2352x1568px · color fundus photograph.
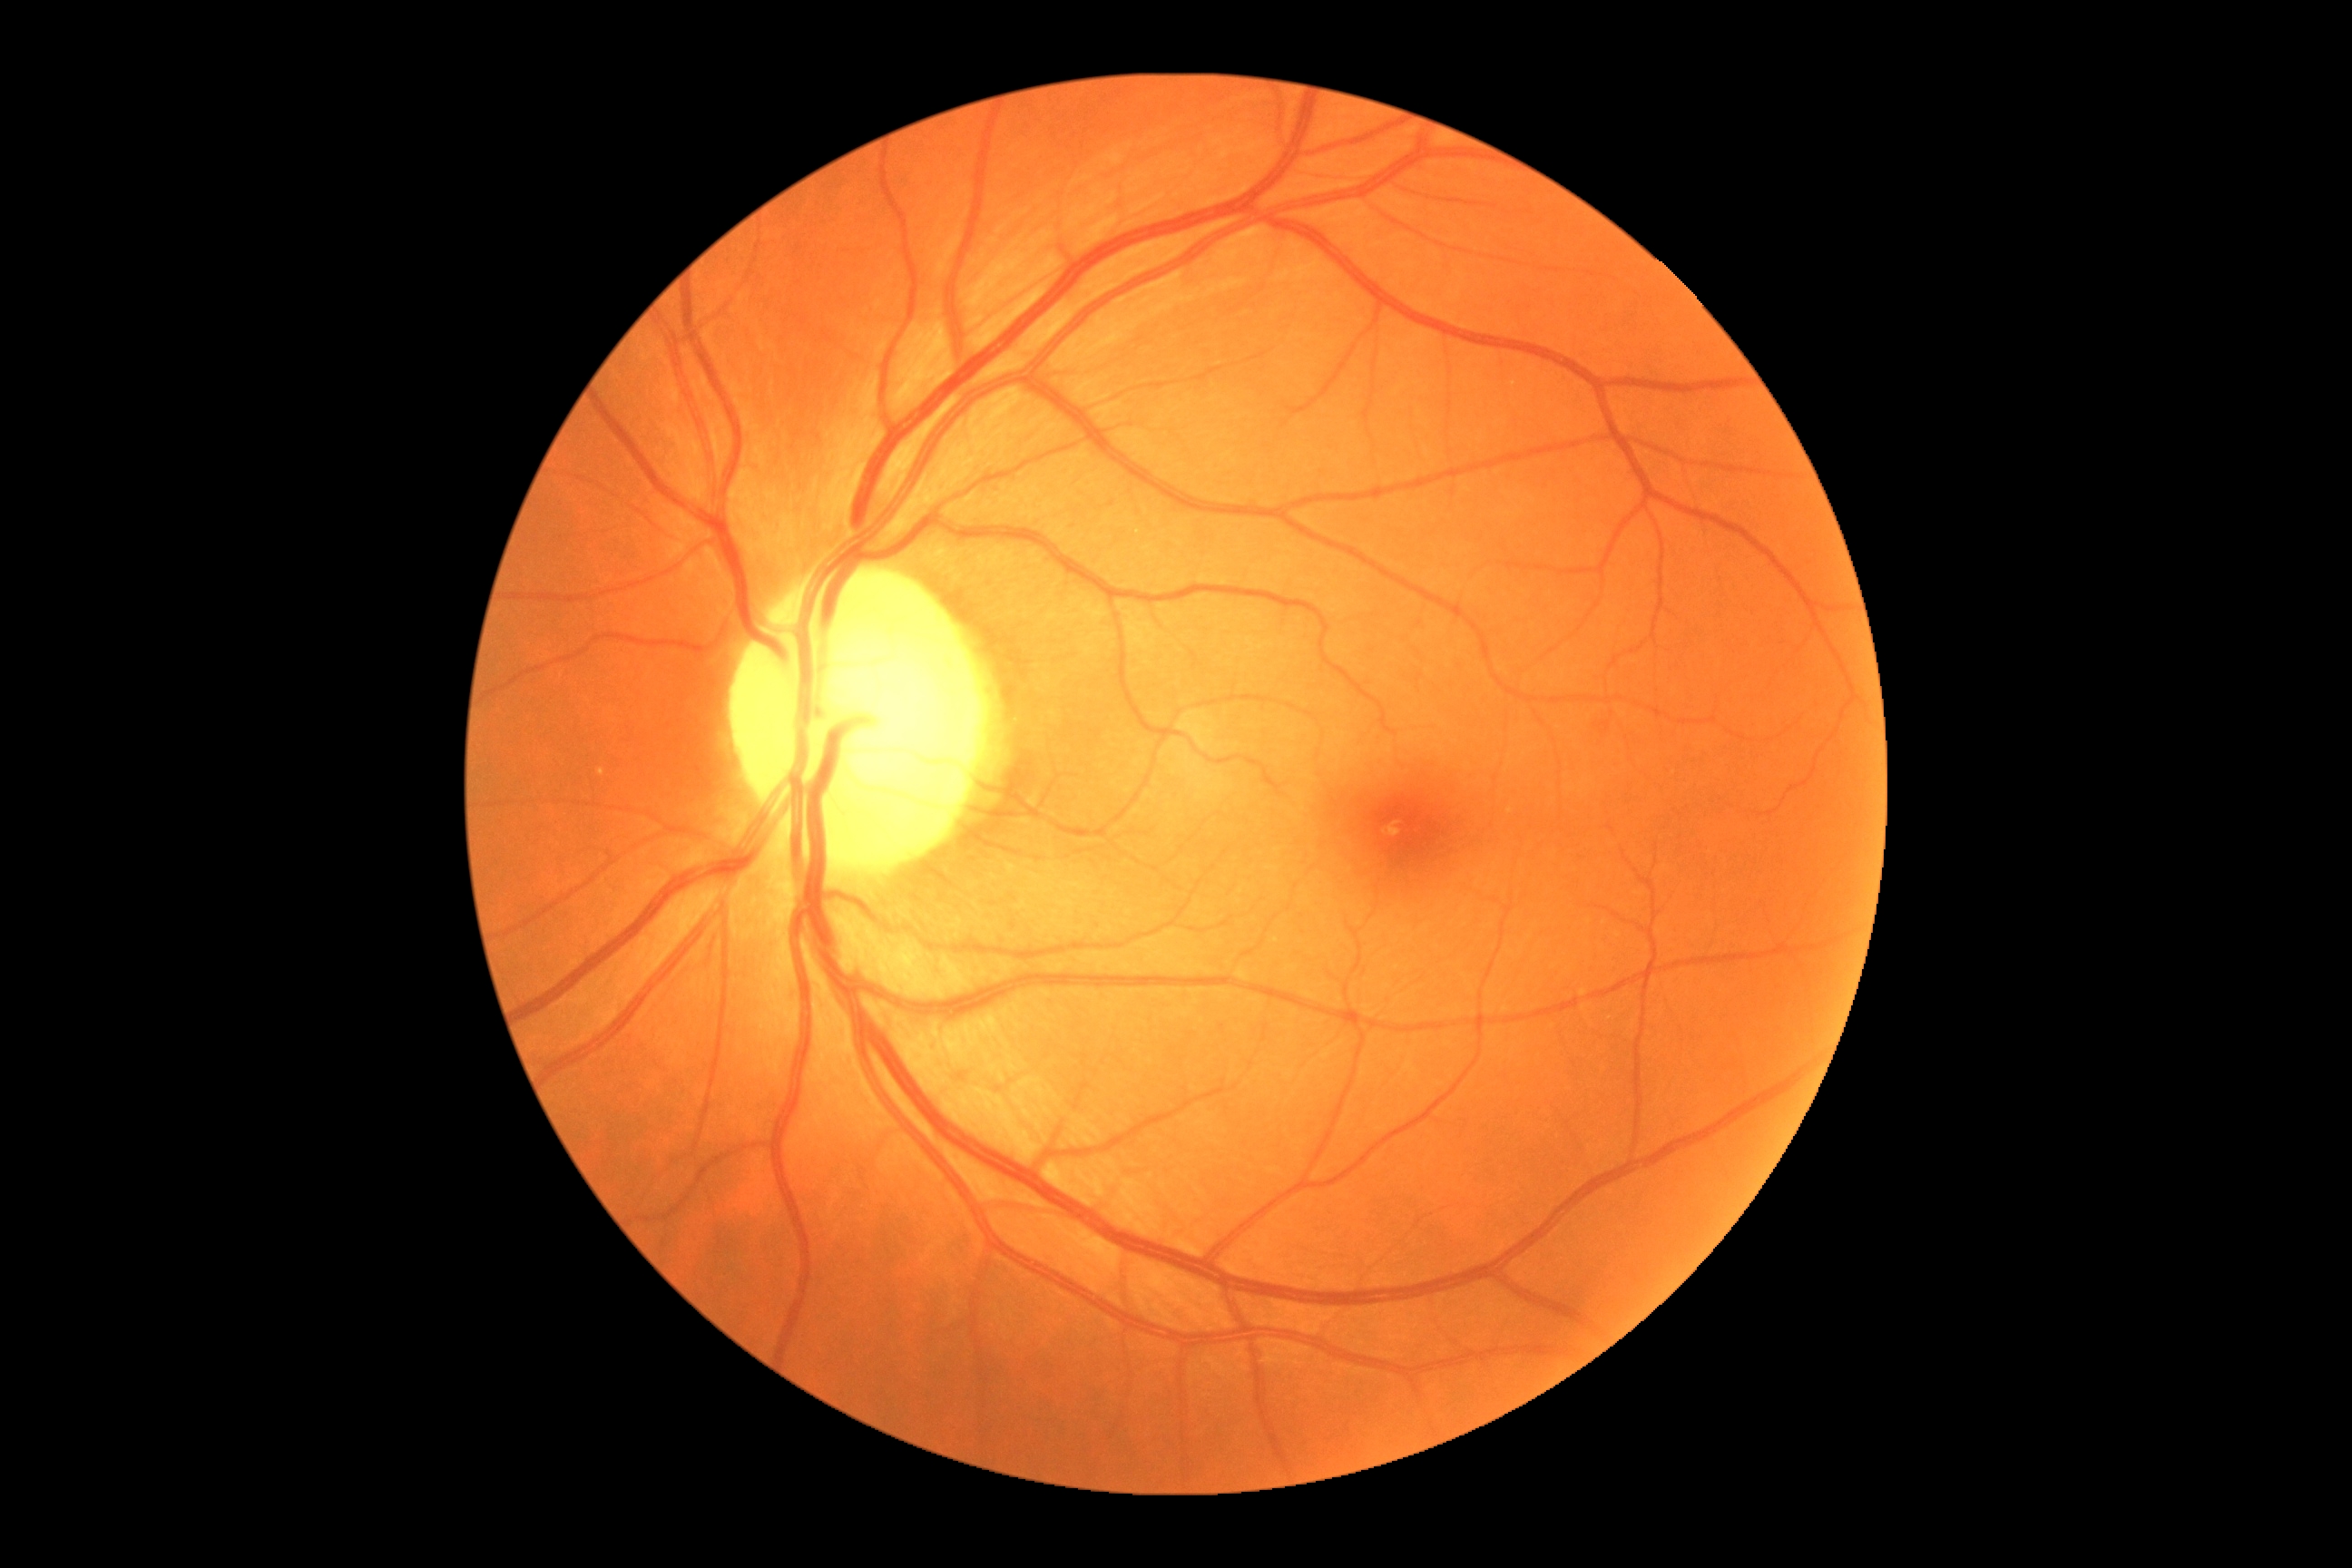 {
  "dr_grade": "grade 0 (no apparent retinopathy)",
  "dr_impression": "negative for DR"
}